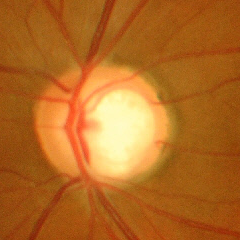 Color fundus photograph showing advanced-stage glaucoma.